Camera: NIDEK AFC-230 · Davis DR grading · no pharmacologic dilation: 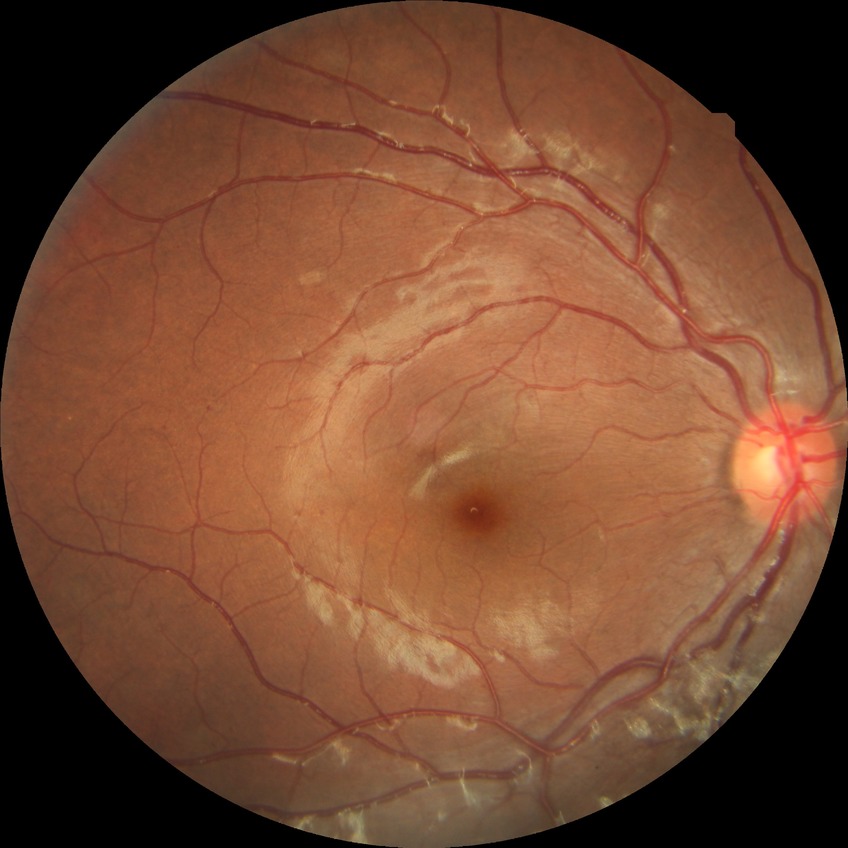

Findings:
* Davis stage: SDR